Color fundus photograph centered on the optic disc:
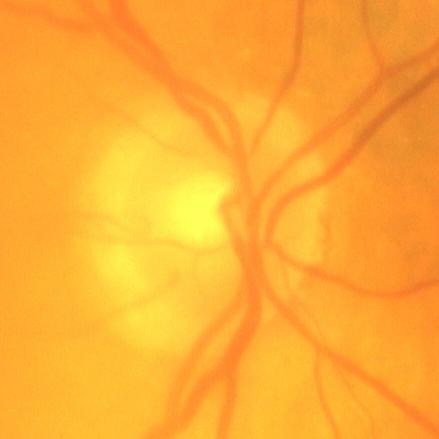 The image shows no glaucomatous optic neuropathy.